DR severity per modified Davis staging. Nonmydriatic
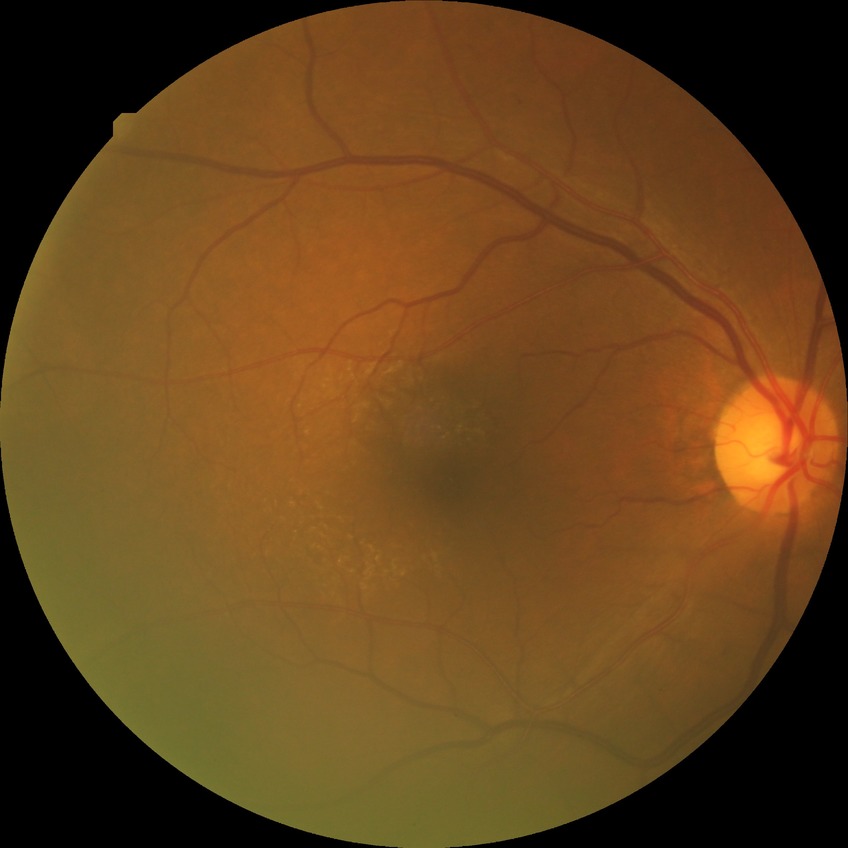

davis_grade: simple diabetic retinopathy (SDR)